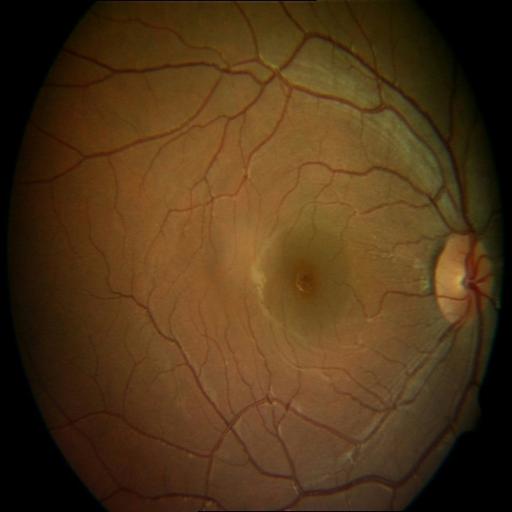

There is evidence of central serous retinopathy.